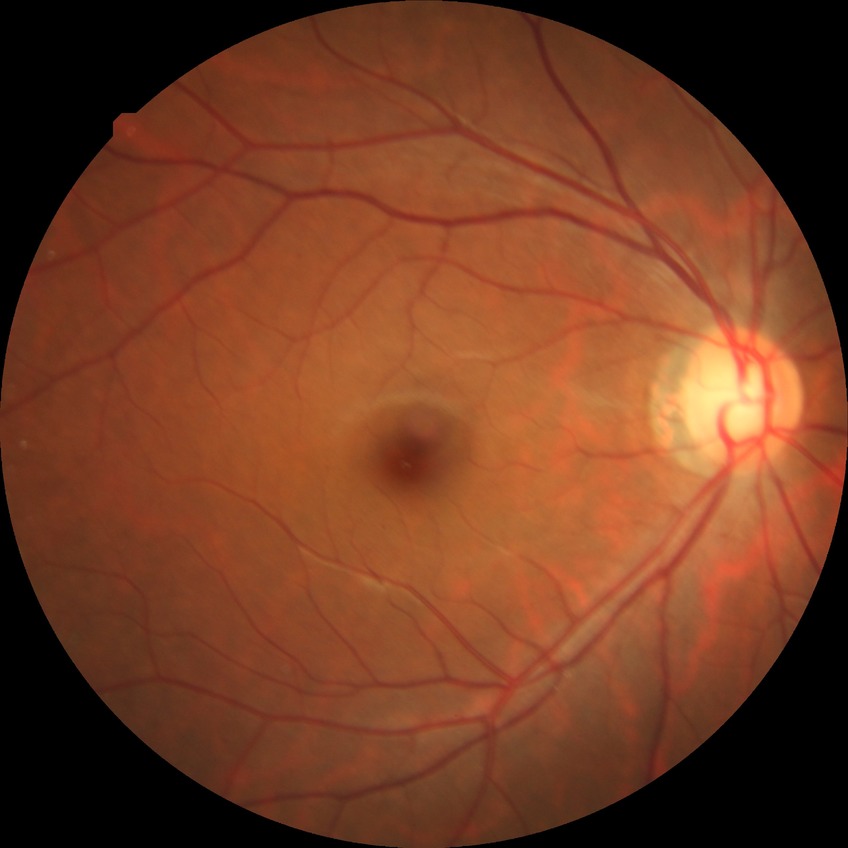

Diabetic retinopathy (DR) is simple diabetic retinopathy (SDR).